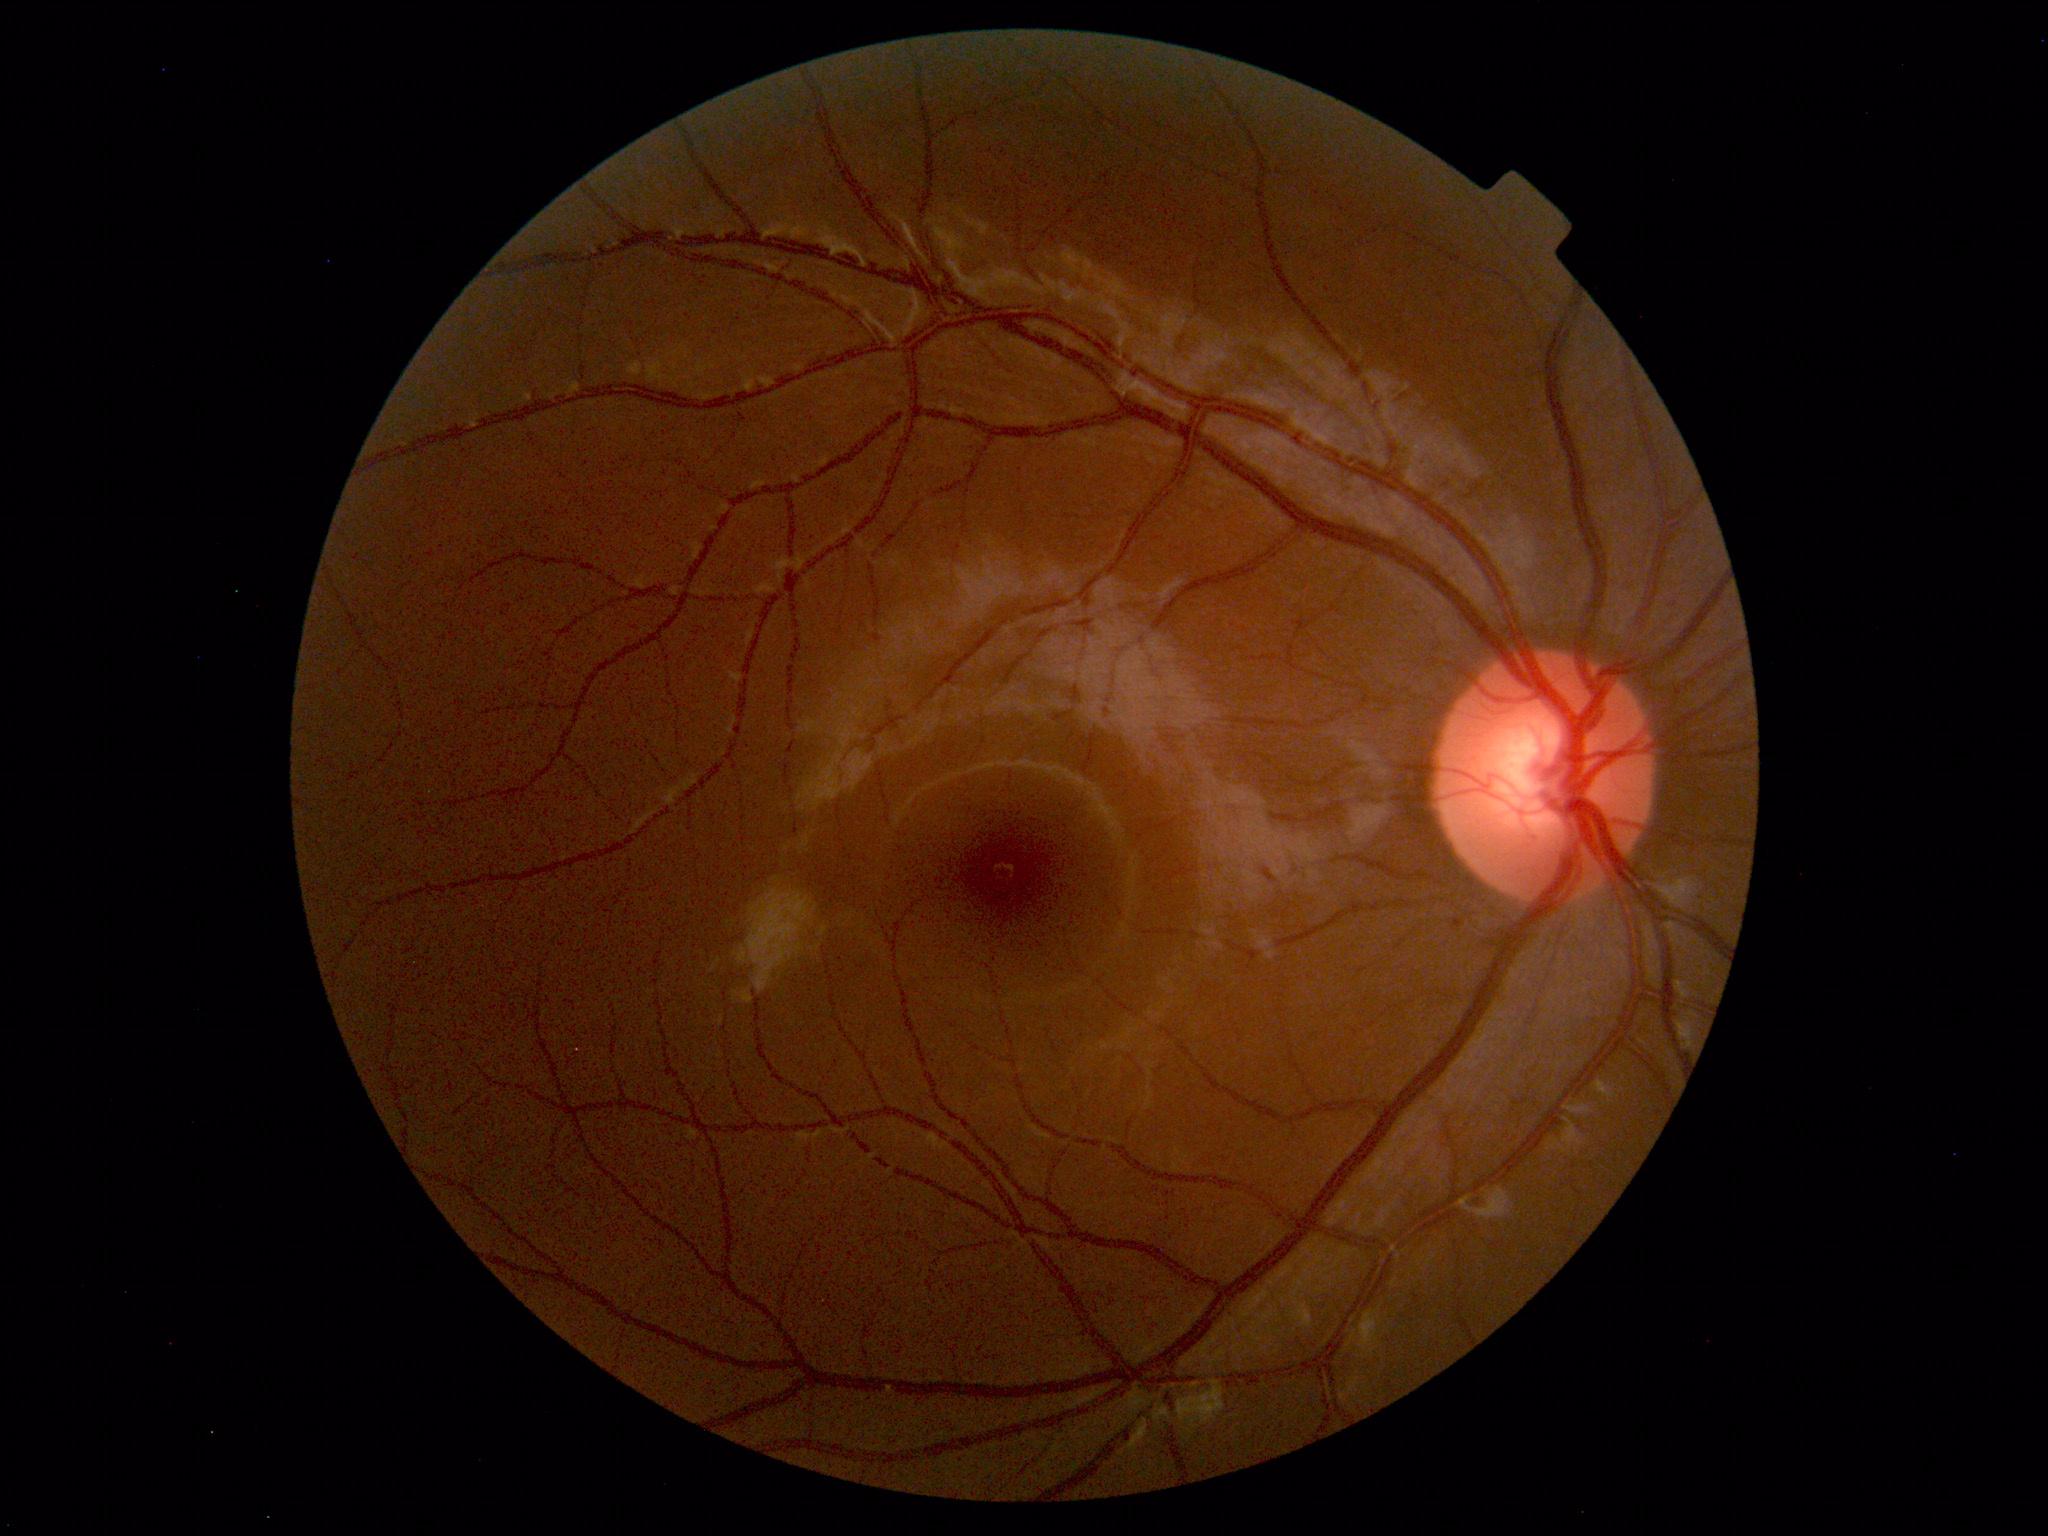

Findings: none. Normal fundus.